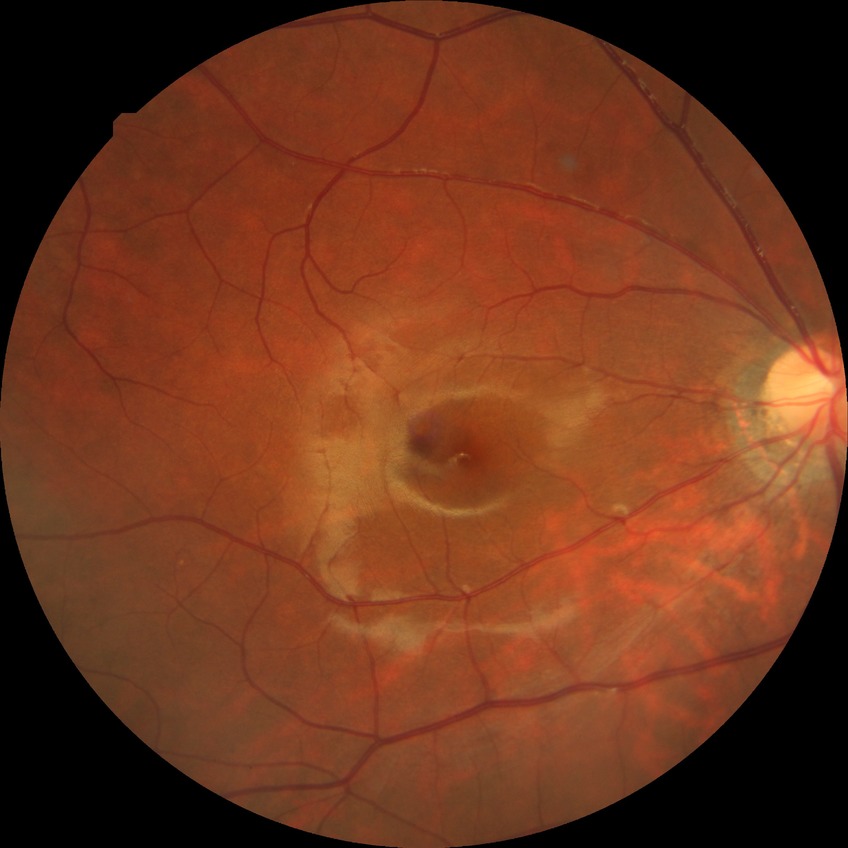 Modified Davis classification is no diabetic retinopathy.